CFP. Graded on the modified Davis scale: 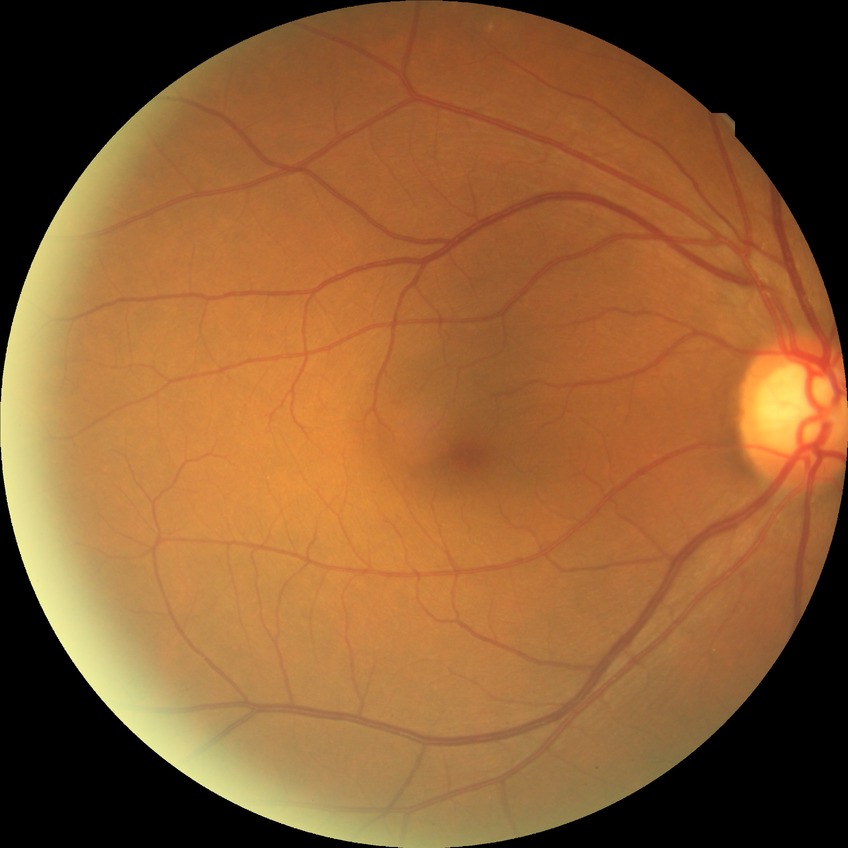

Diabetic retinopathy stage: no diabetic retinopathy.